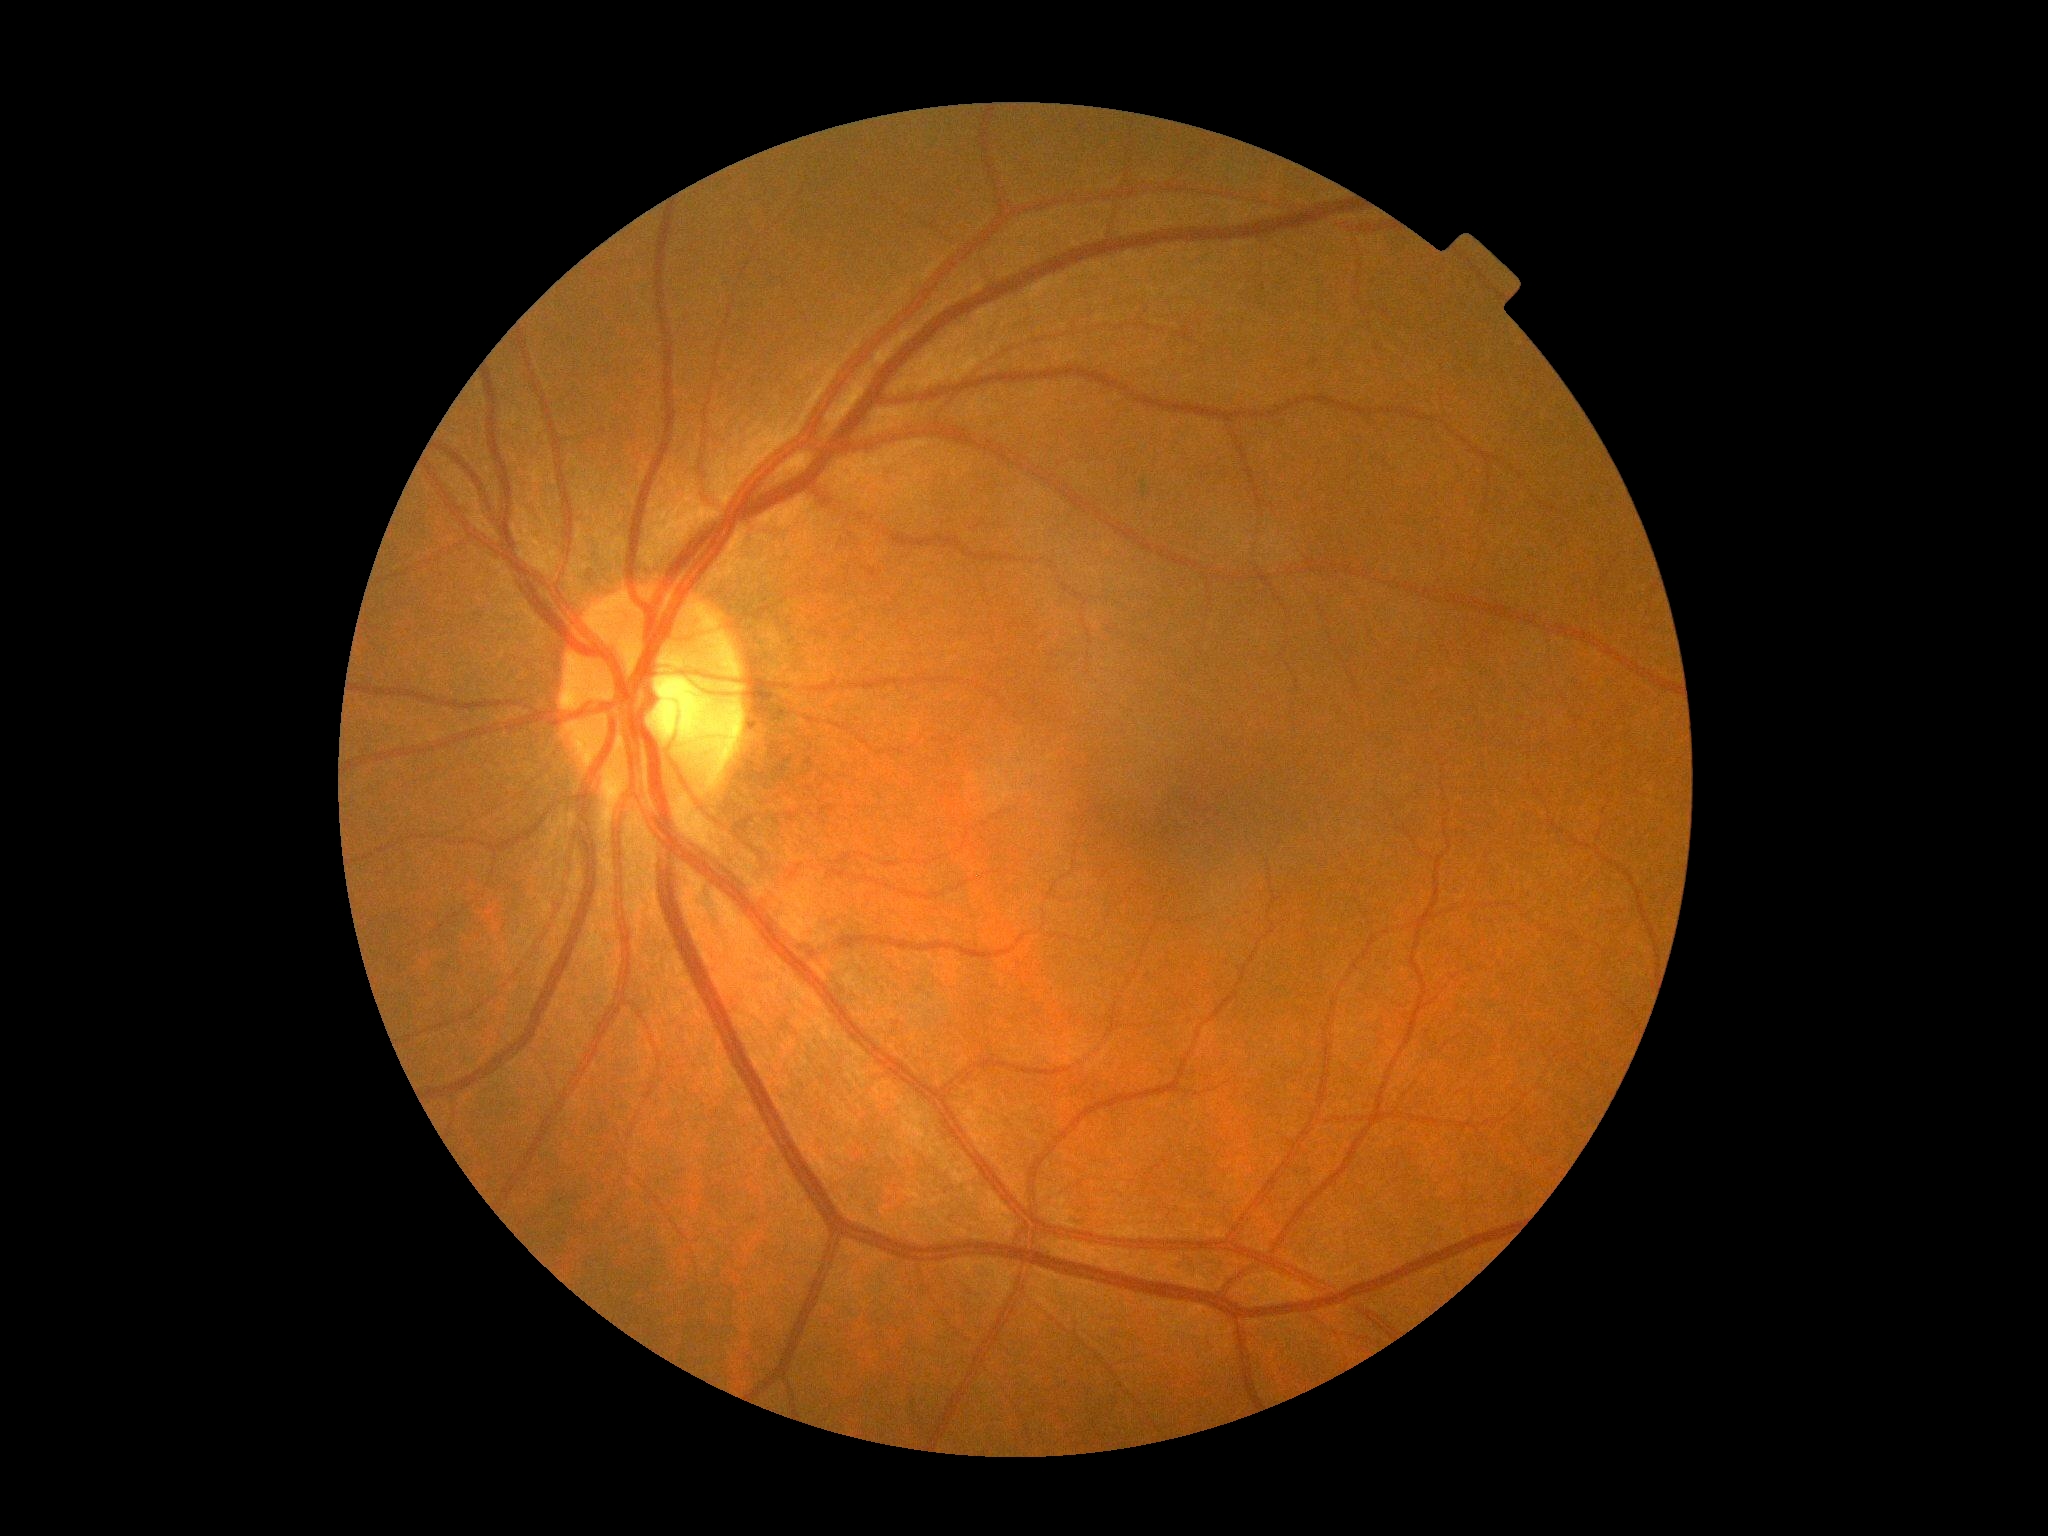

DR stage is grade 0.